45° FOV; no pharmacologic dilation:
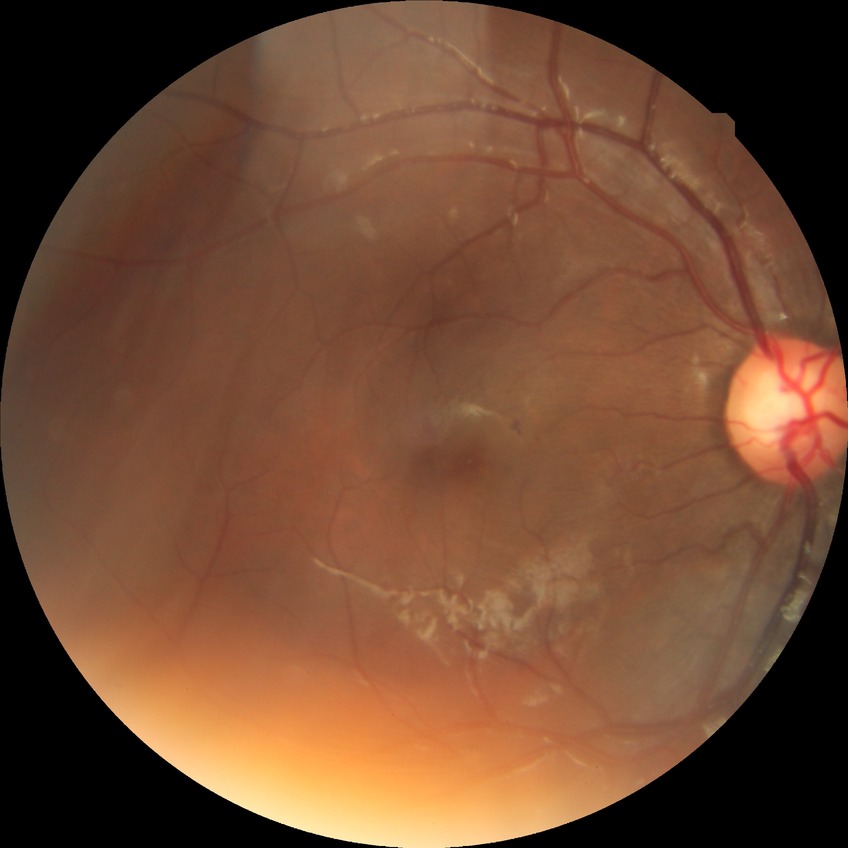

modified Davis grading@simple diabetic retinopathy.